Modified Davis grading.
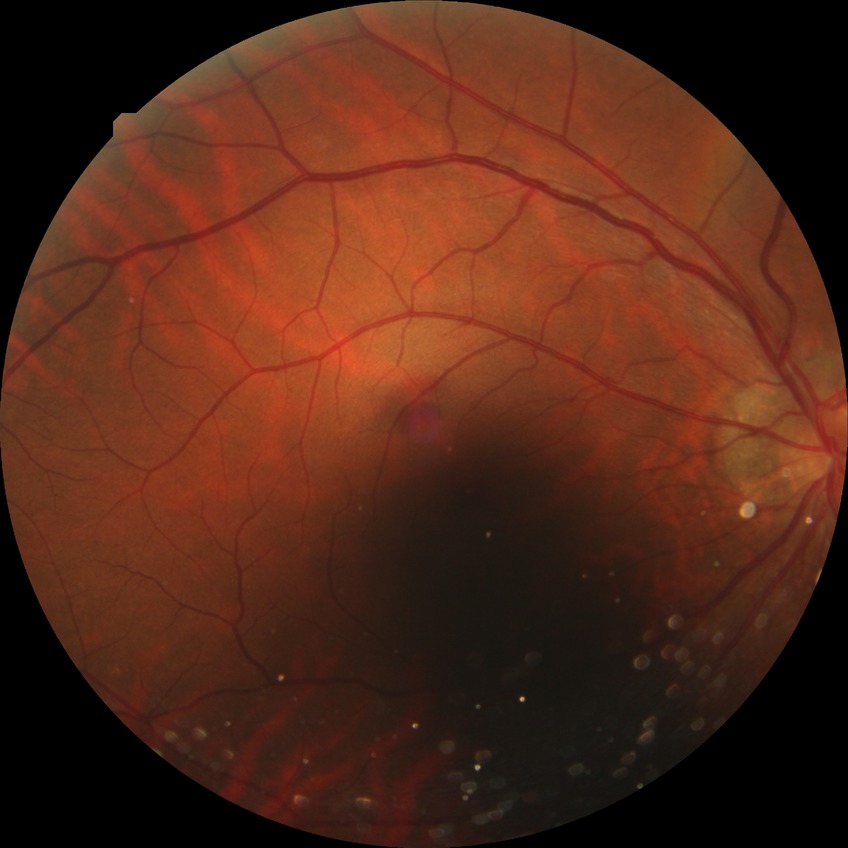
Findings:
– diabetic retinopathy (DR): NDR (no diabetic retinopathy)